2048 by 1536 pixels:
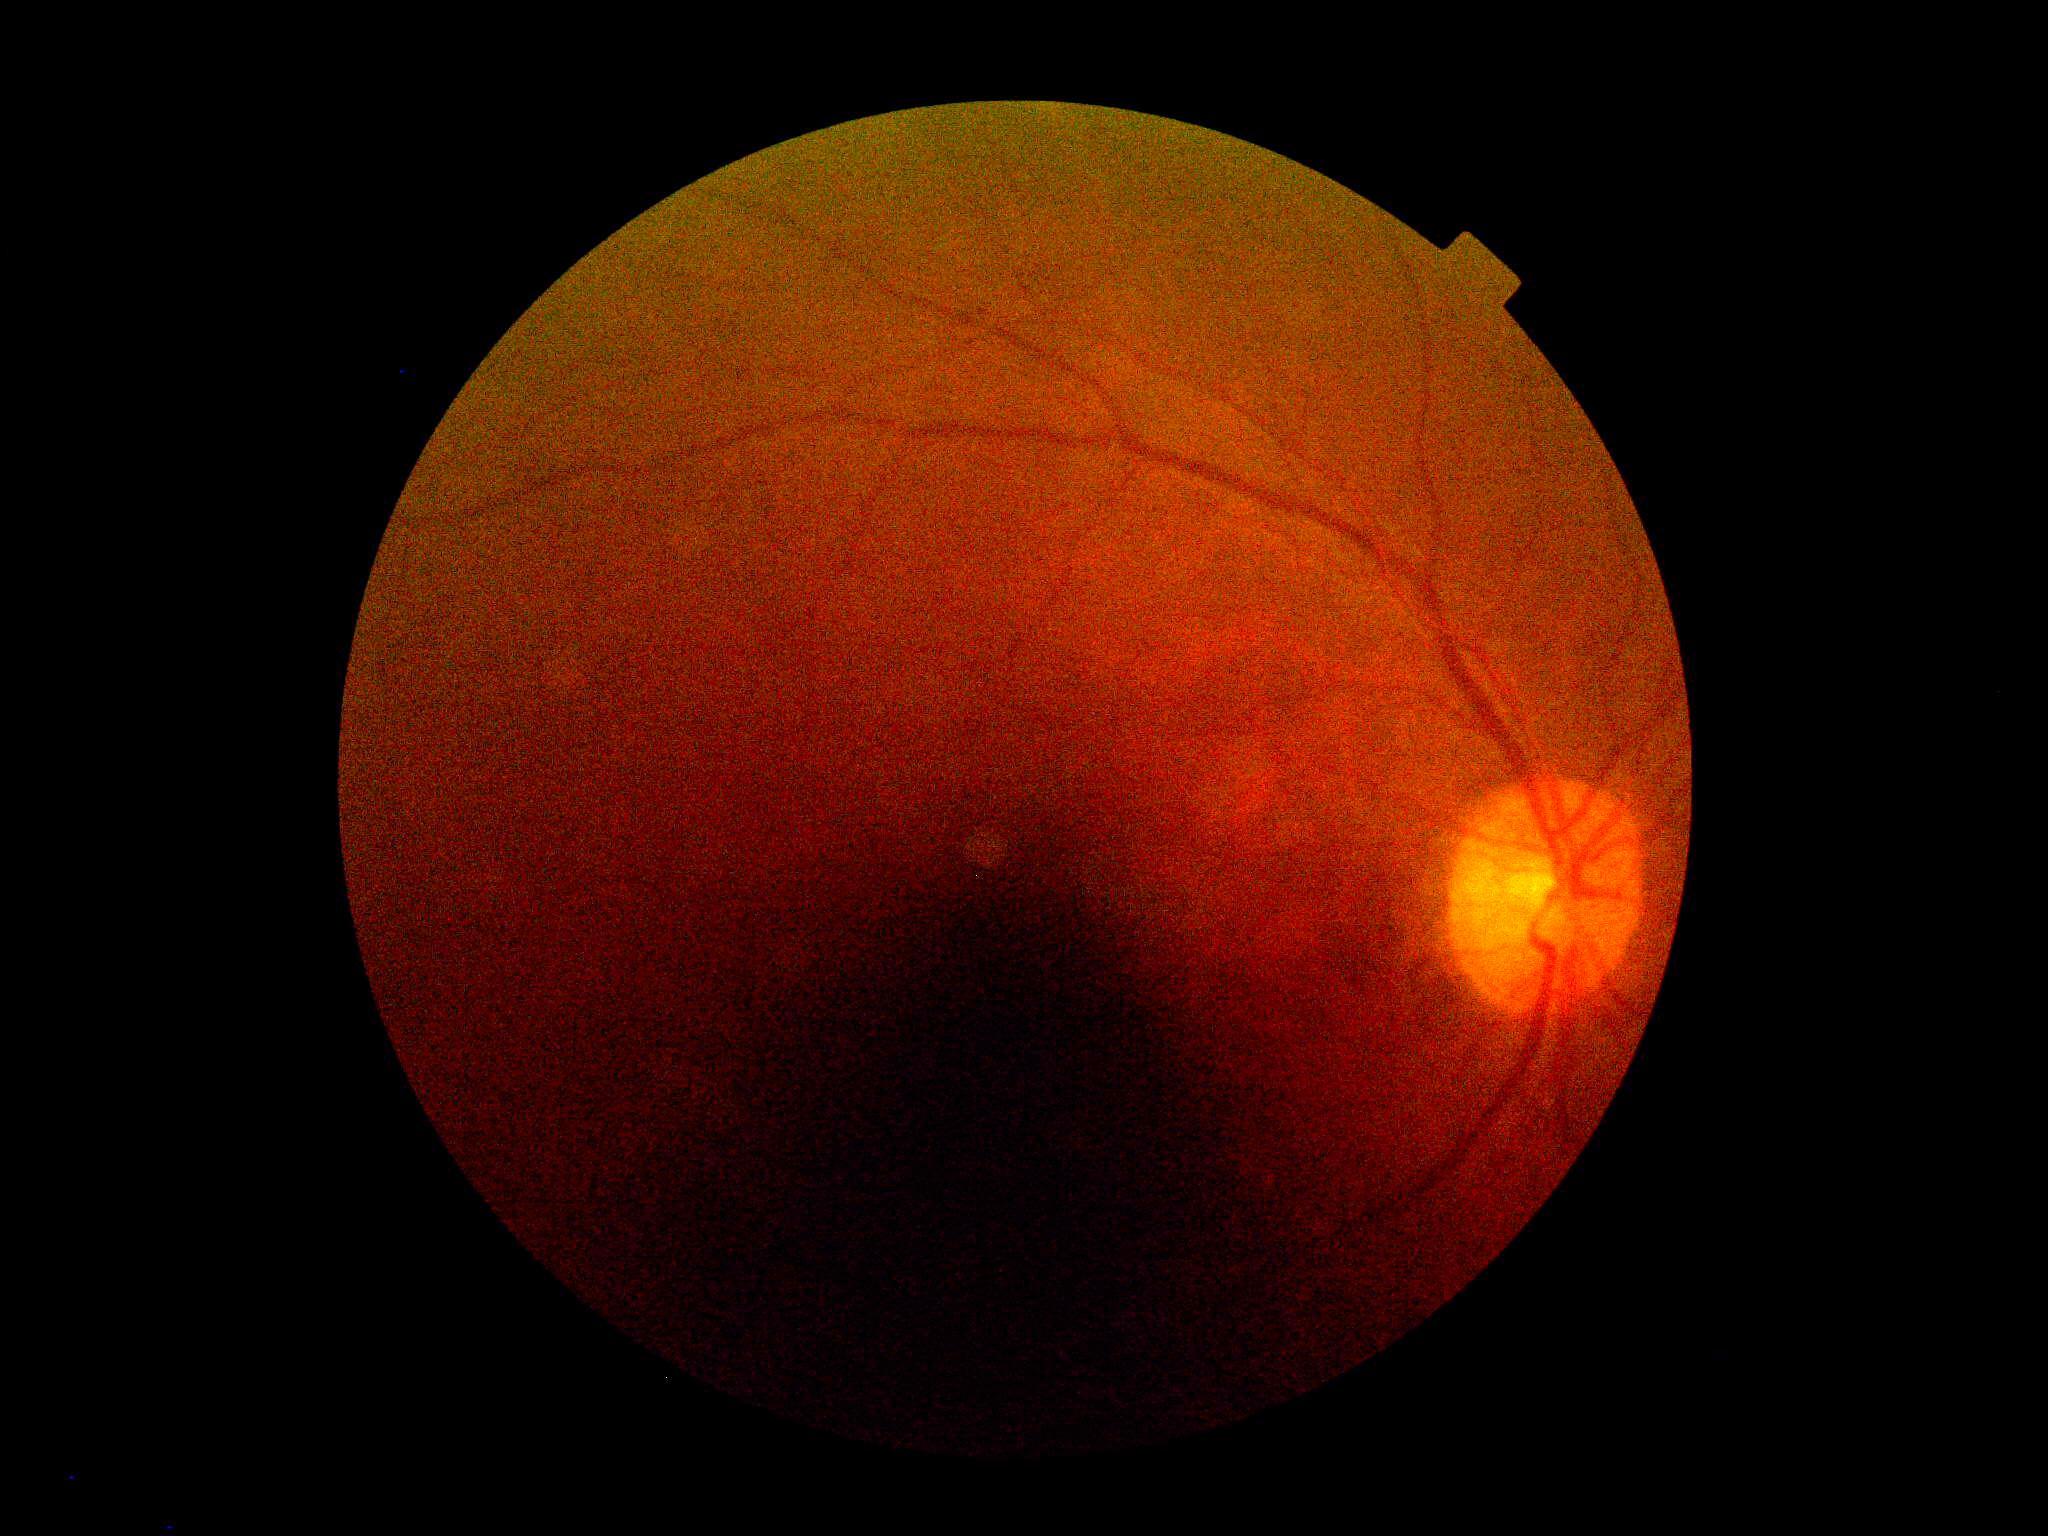   dr_grade: ungradable due to poor image quality